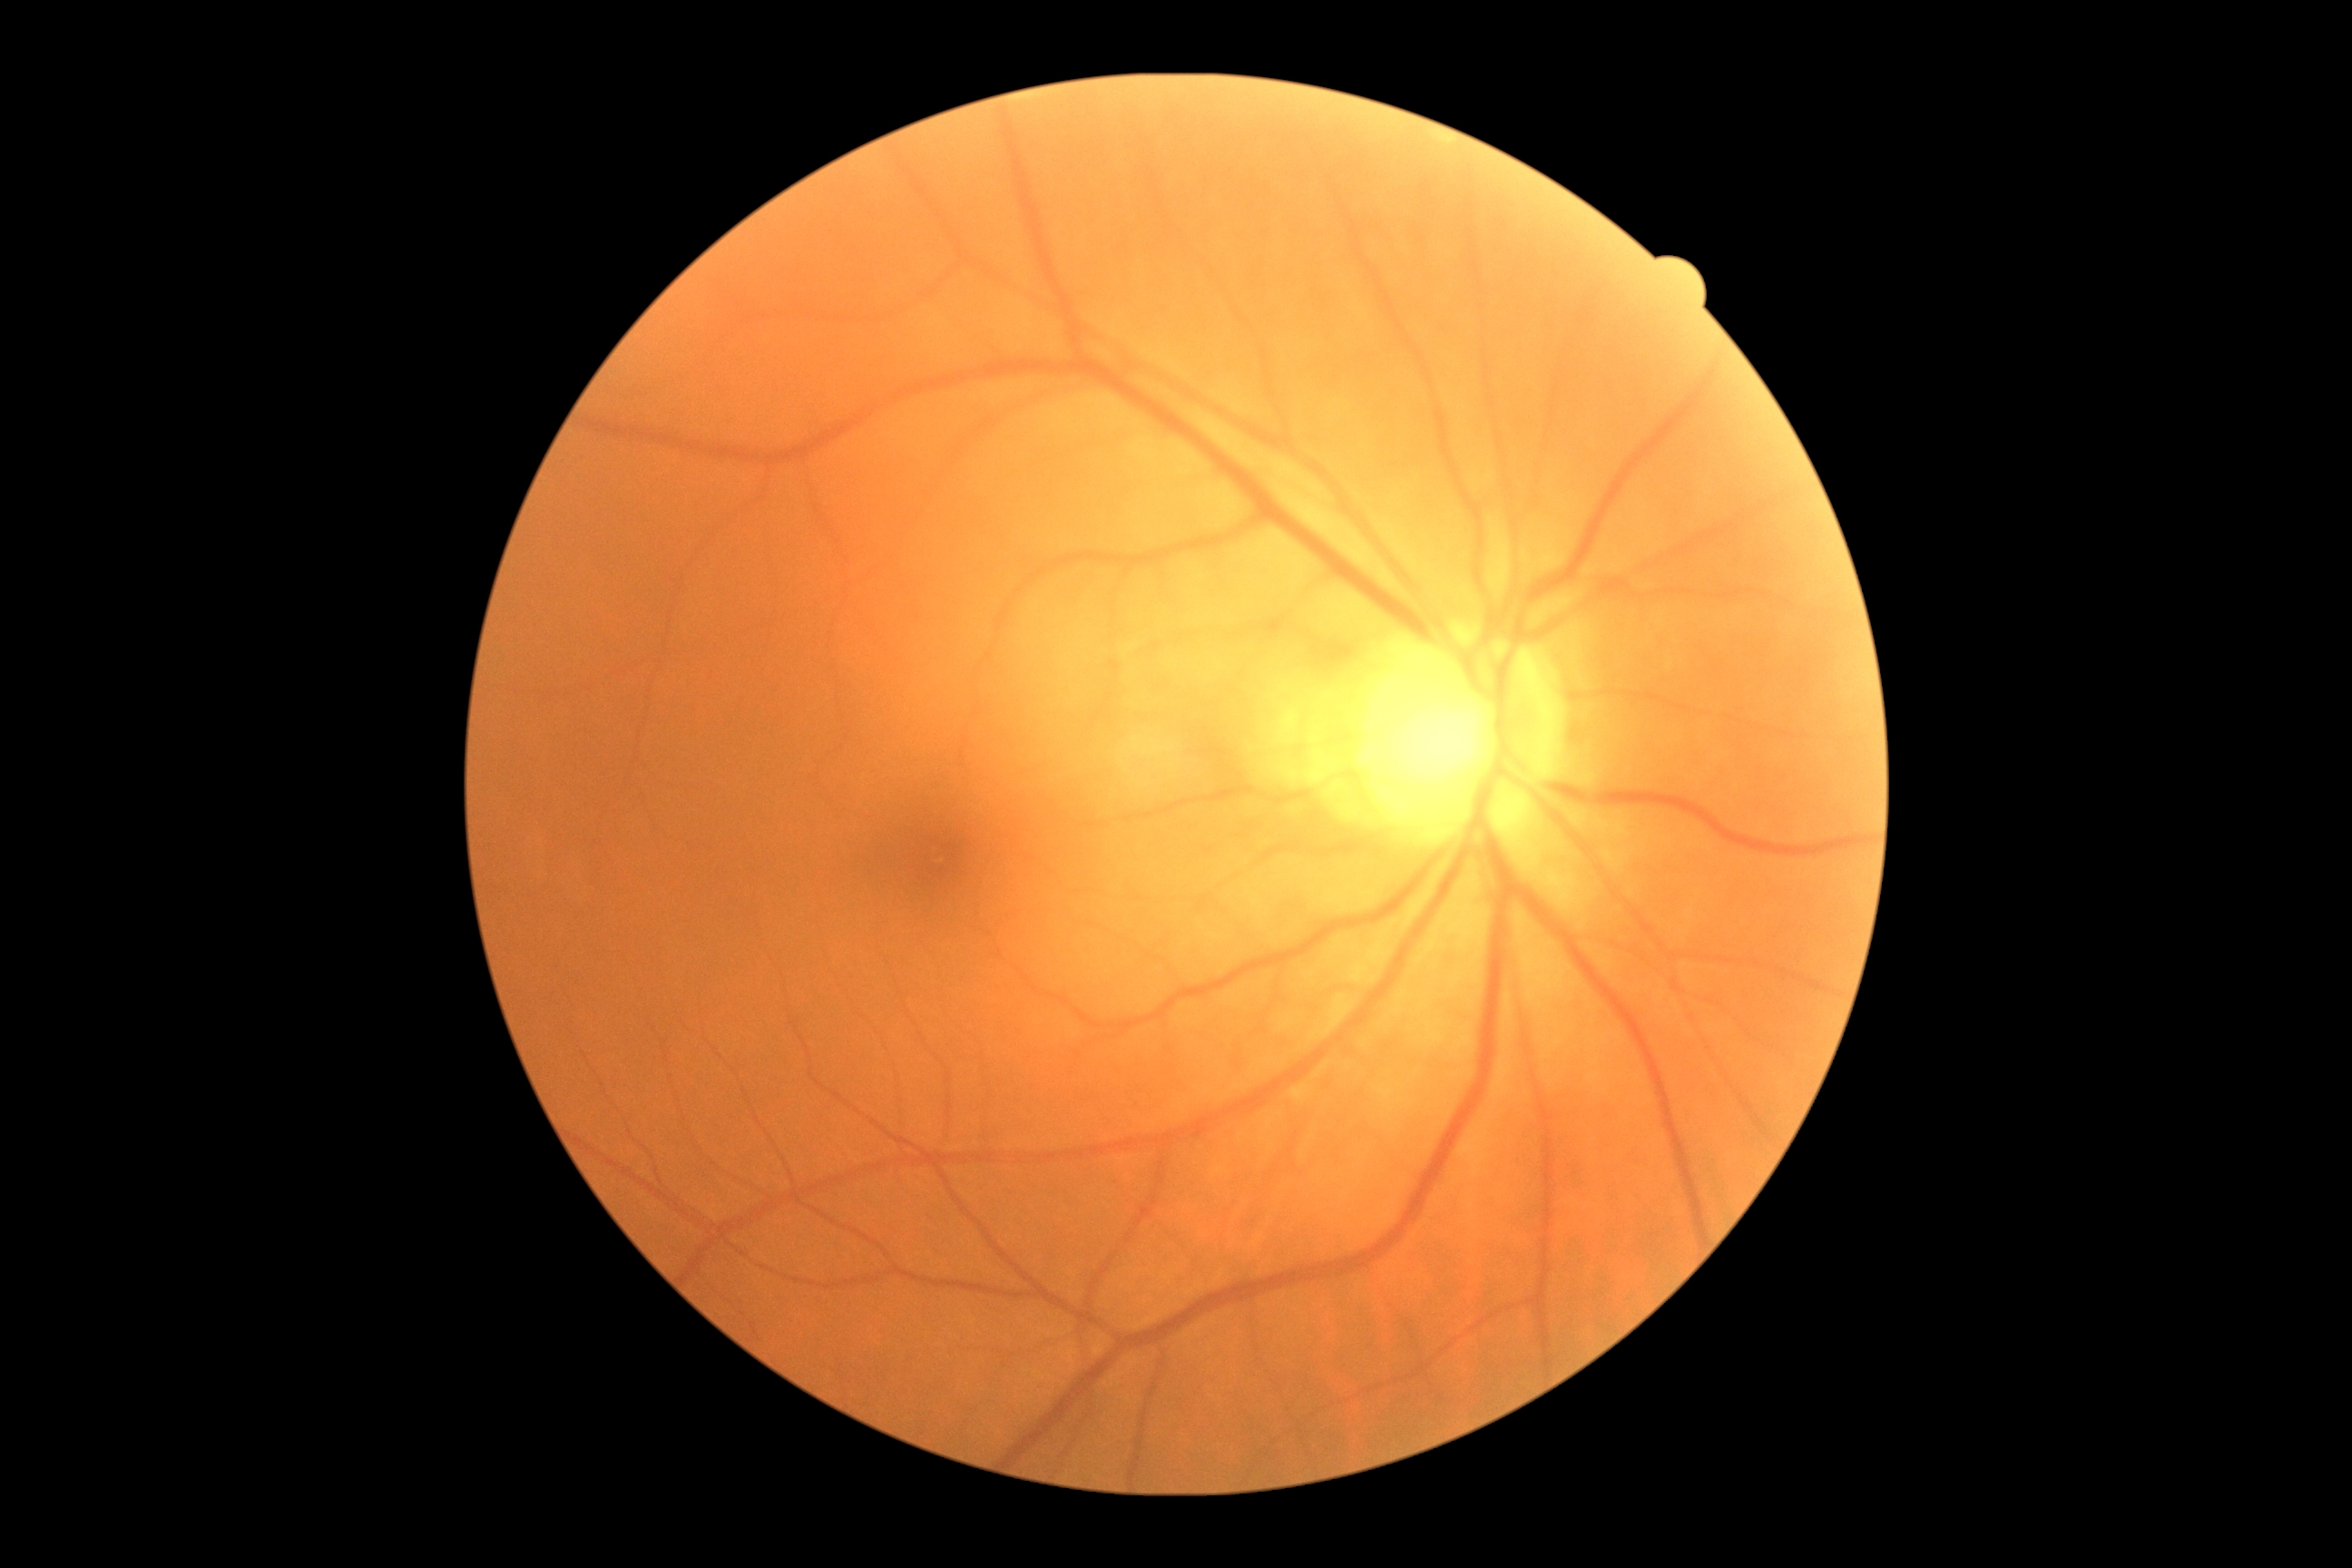

DR stage is no apparent retinopathy (grade 0).
No signs of diabetic retinopathy.